Color fundus photograph, image size 1932x1932.
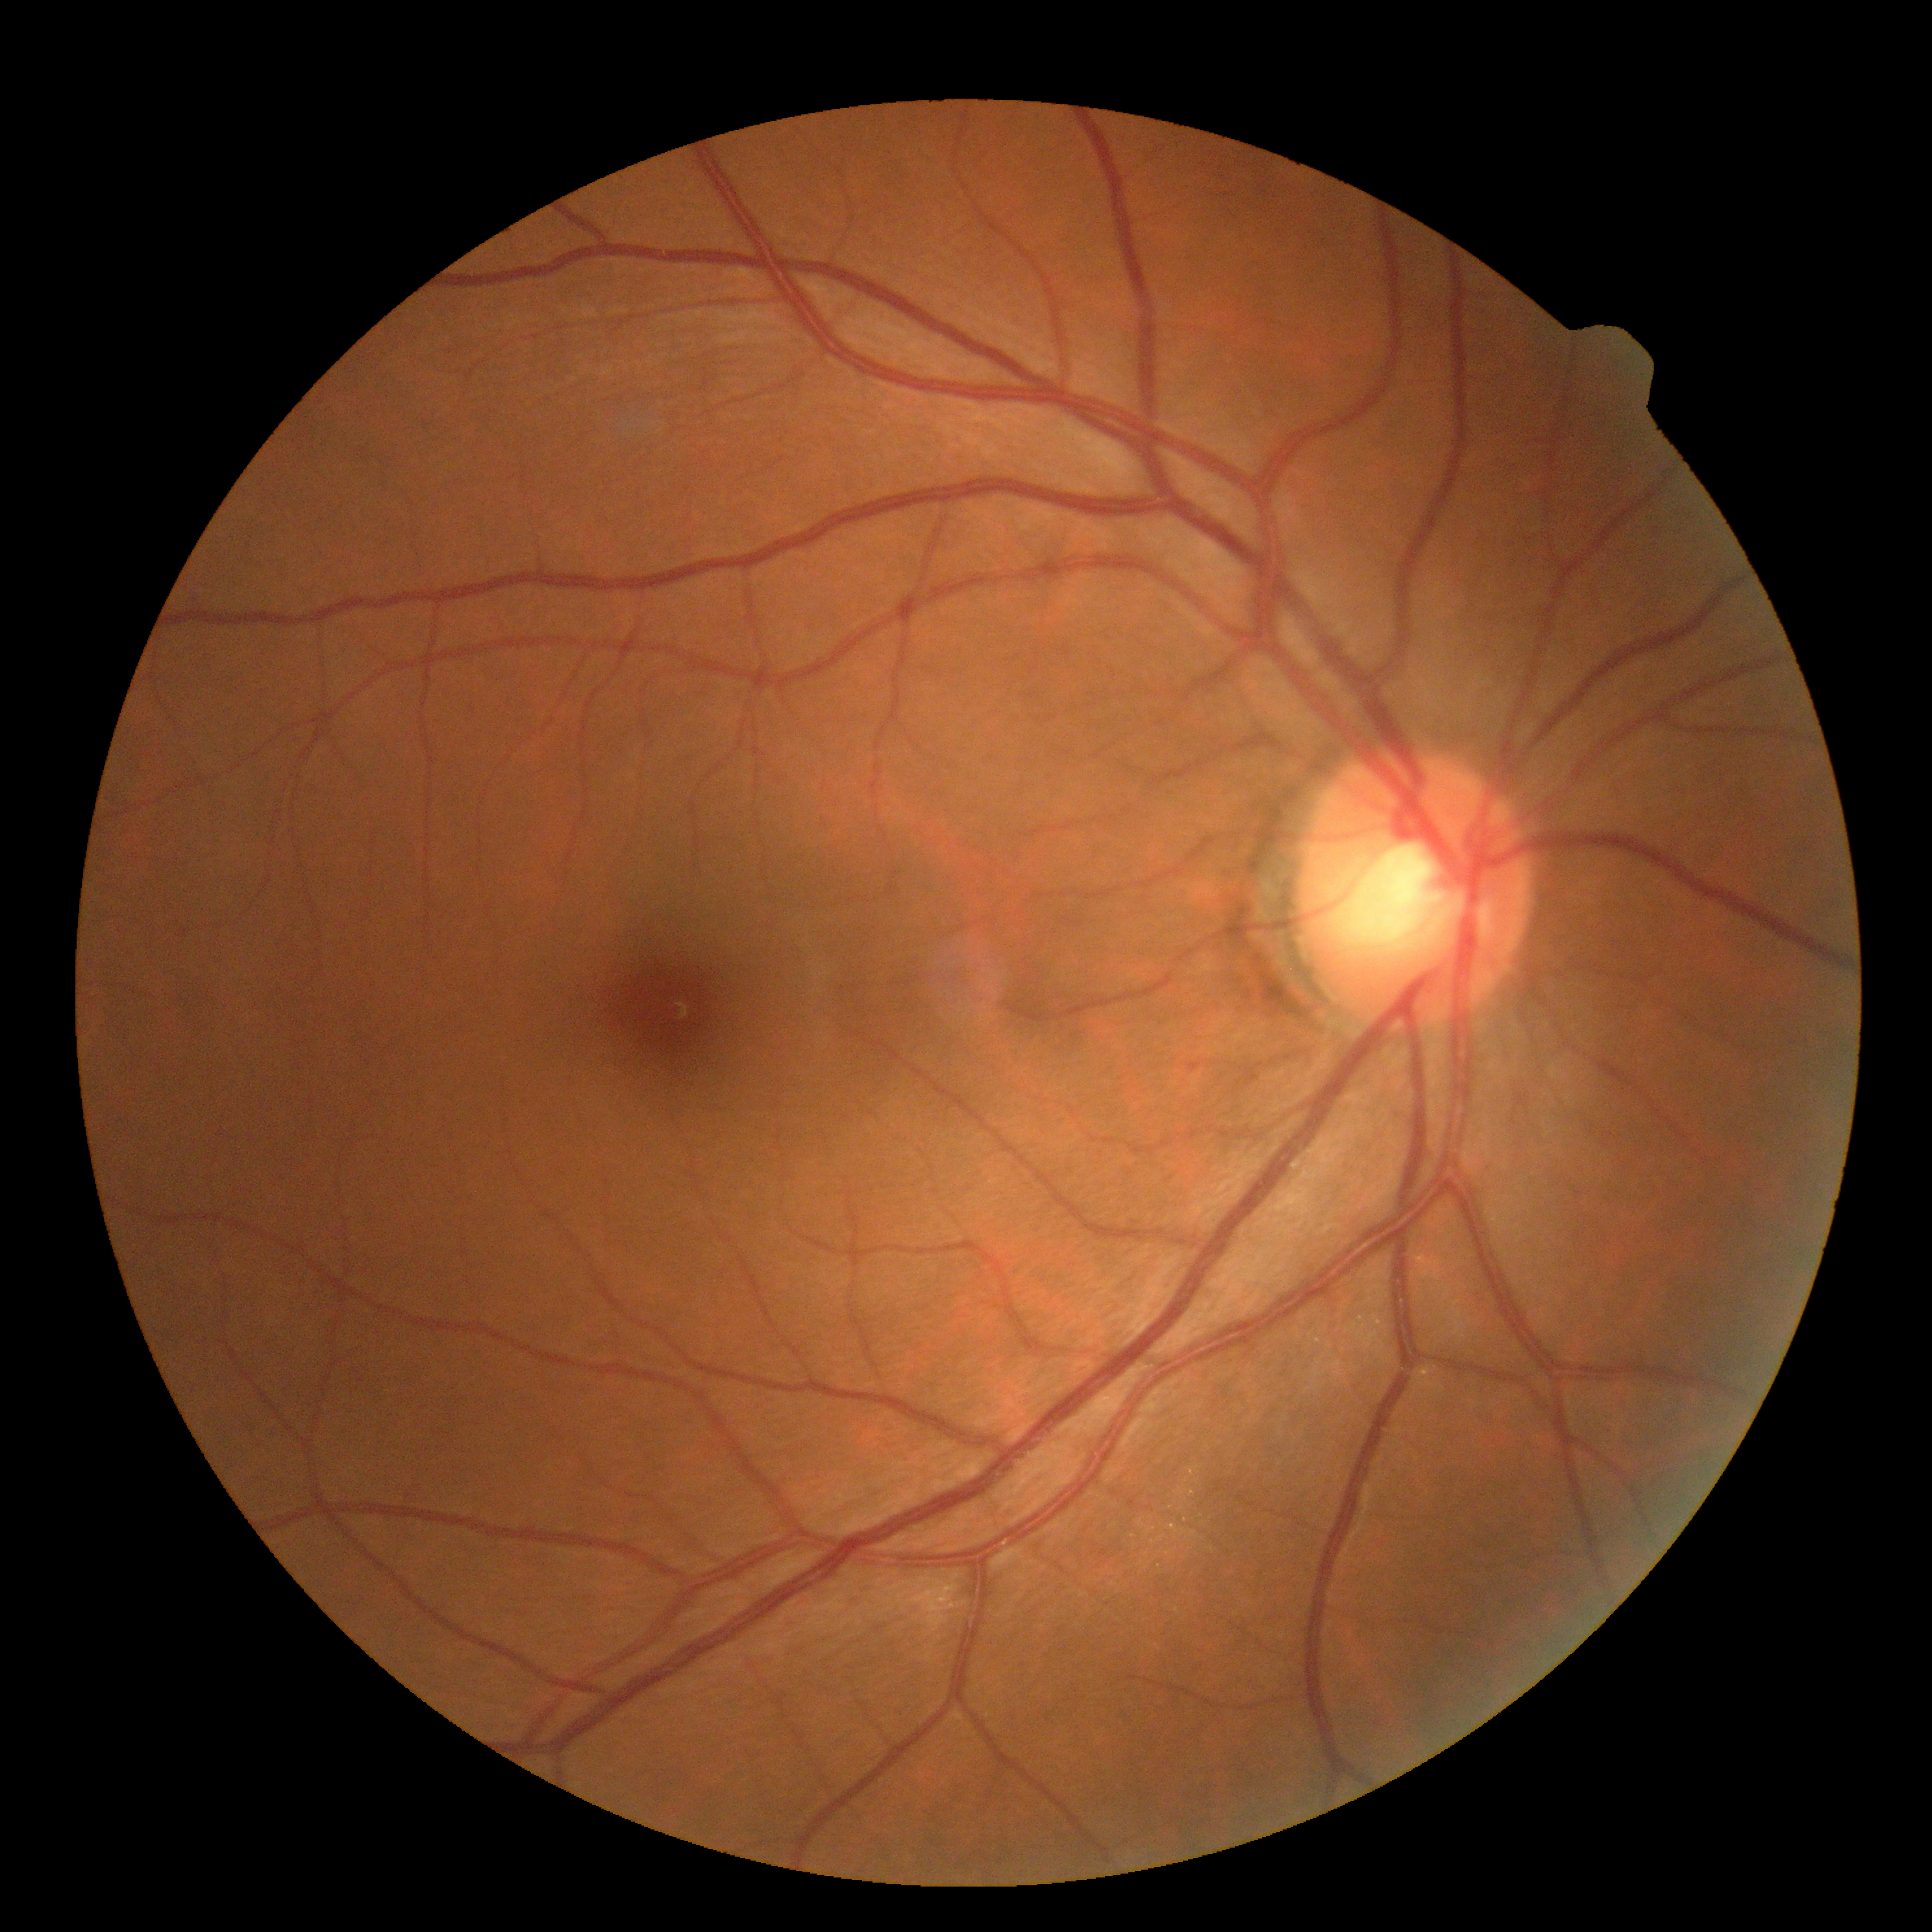 DR grade is 0 (no apparent retinopathy).